CFP
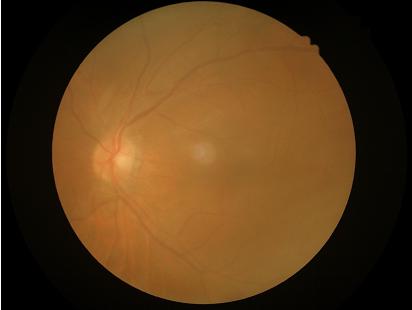
{"overall_quality": "poor and difficult to use diagnostically", "illumination": "good illumination and color balance", "contrast": "low, vessels and details hard to distinguish", "clarity": "reduced sharpness with visible blur"}